2212 x 1659 pixels.
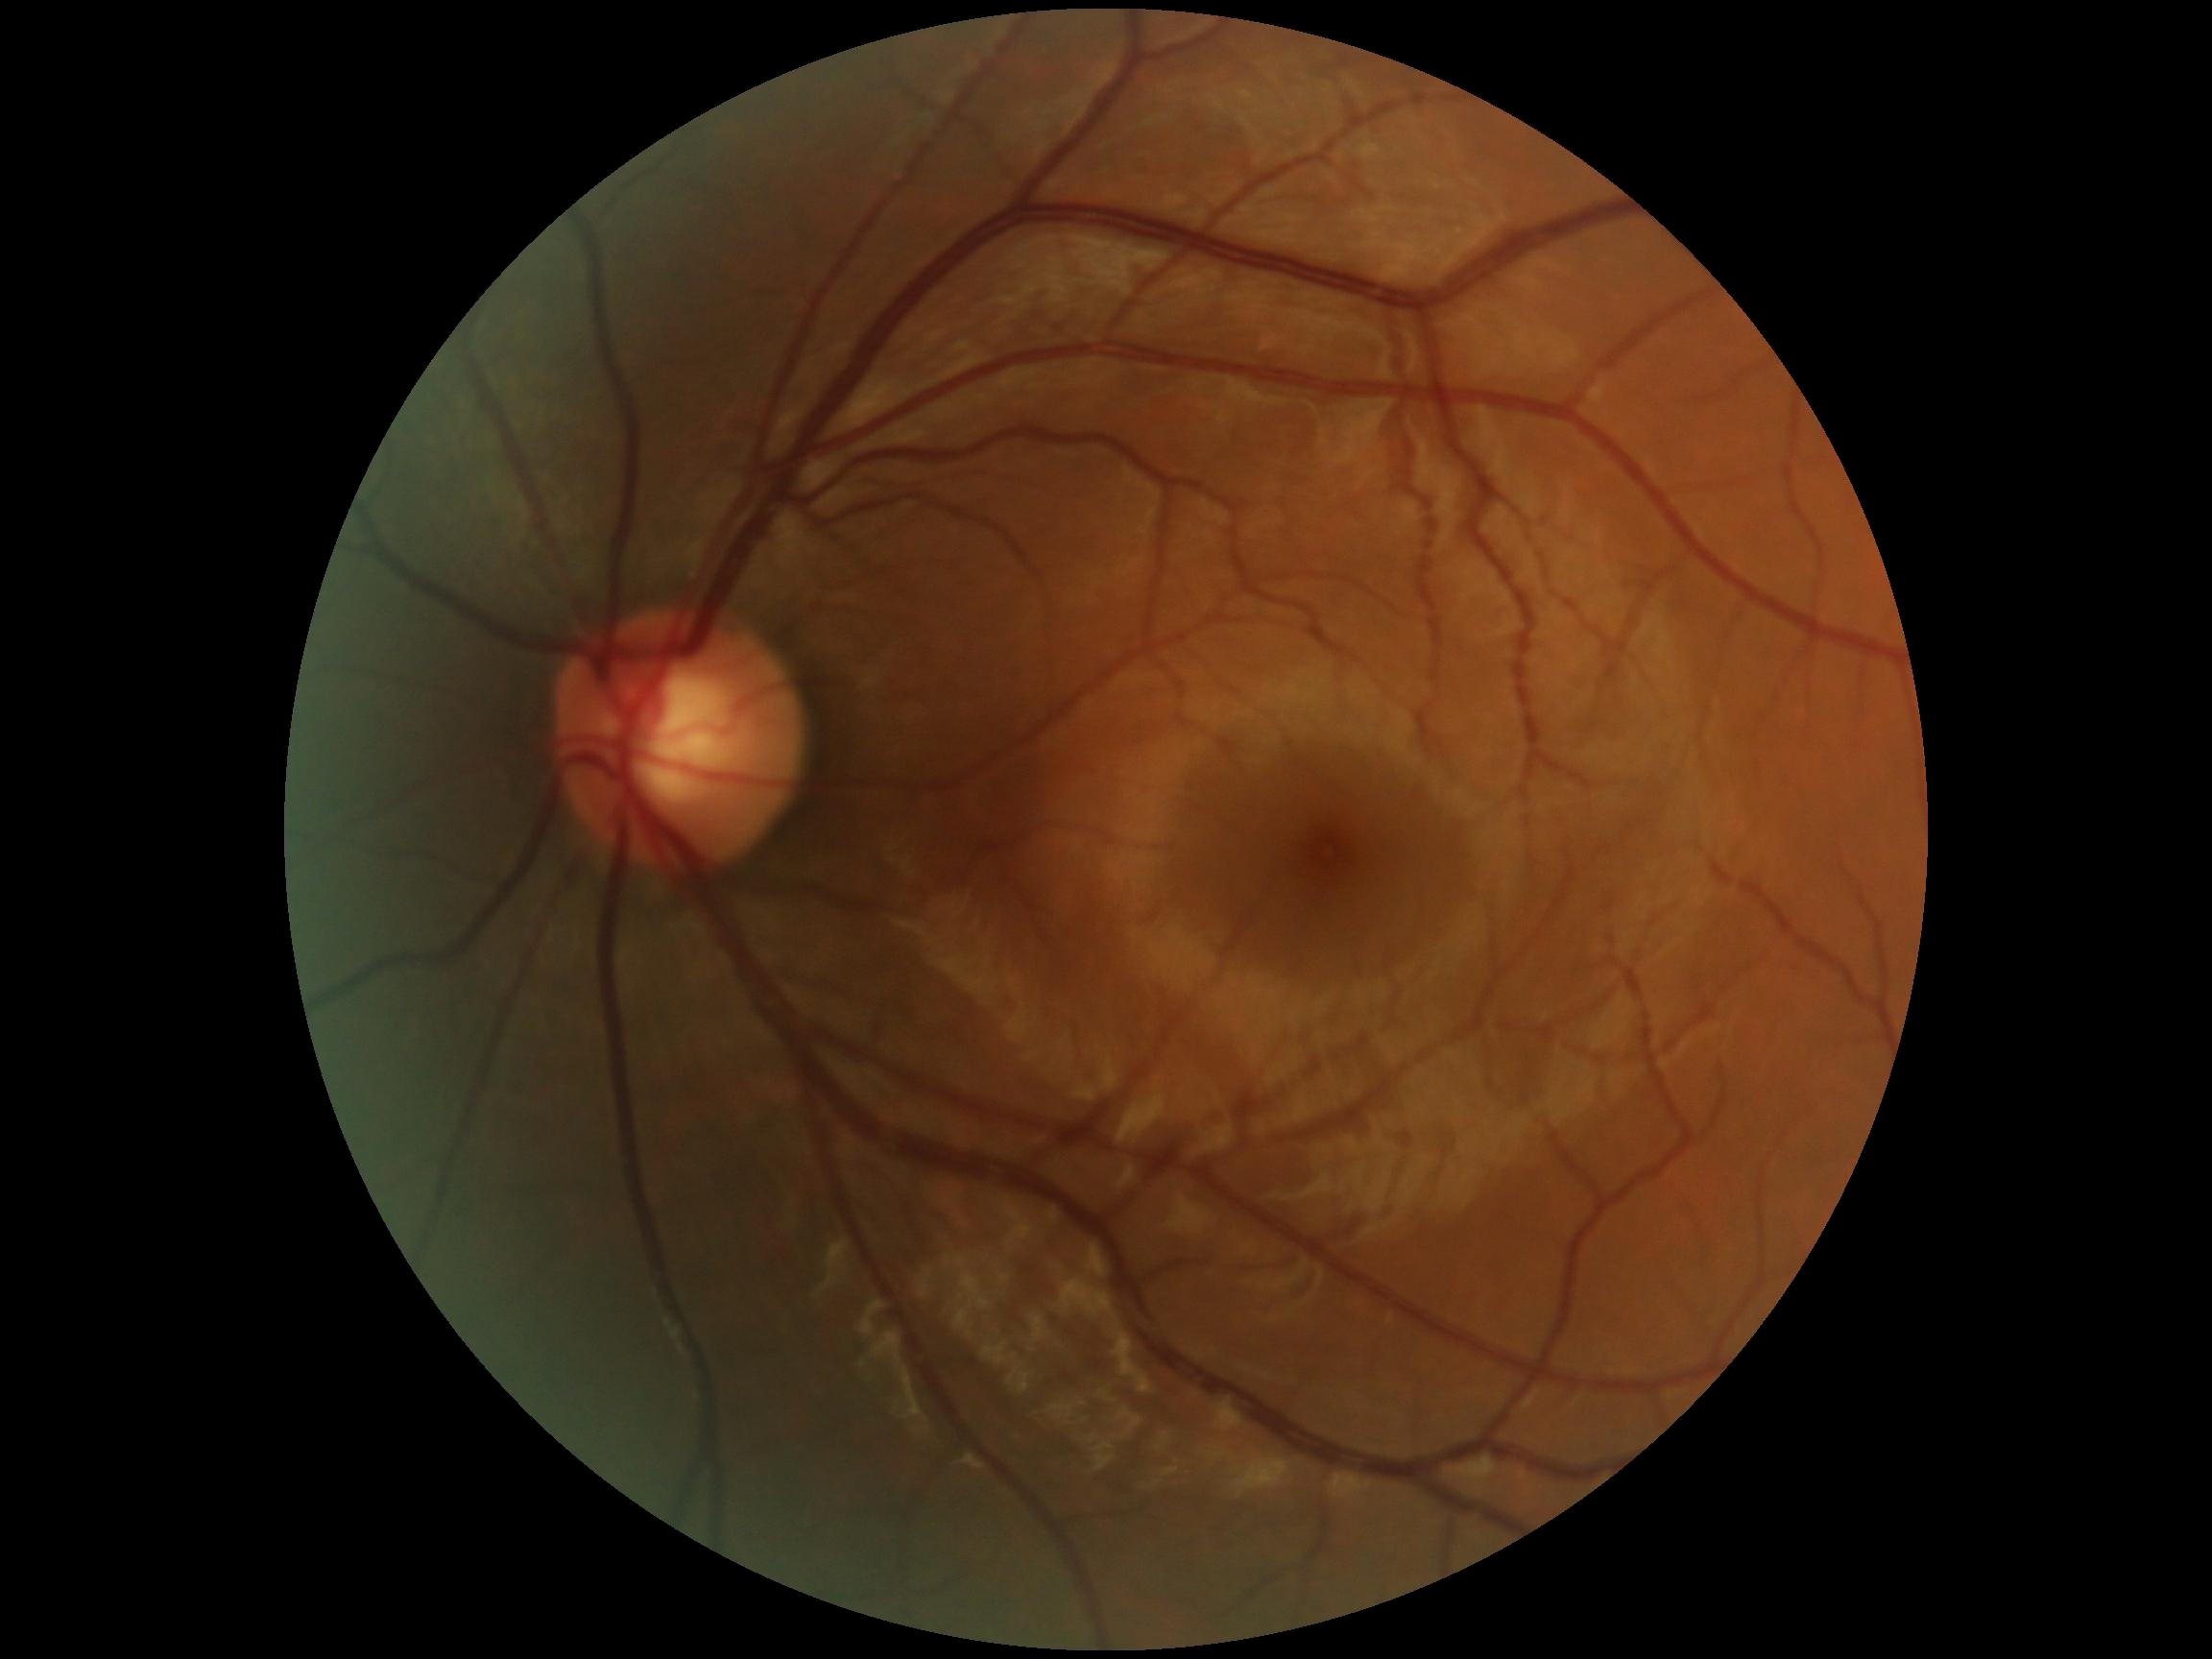

  dr_impression: negative for DR
  dr_grade: no apparent diabetic retinopathy (grade 0)